Retinal fundus photograph:
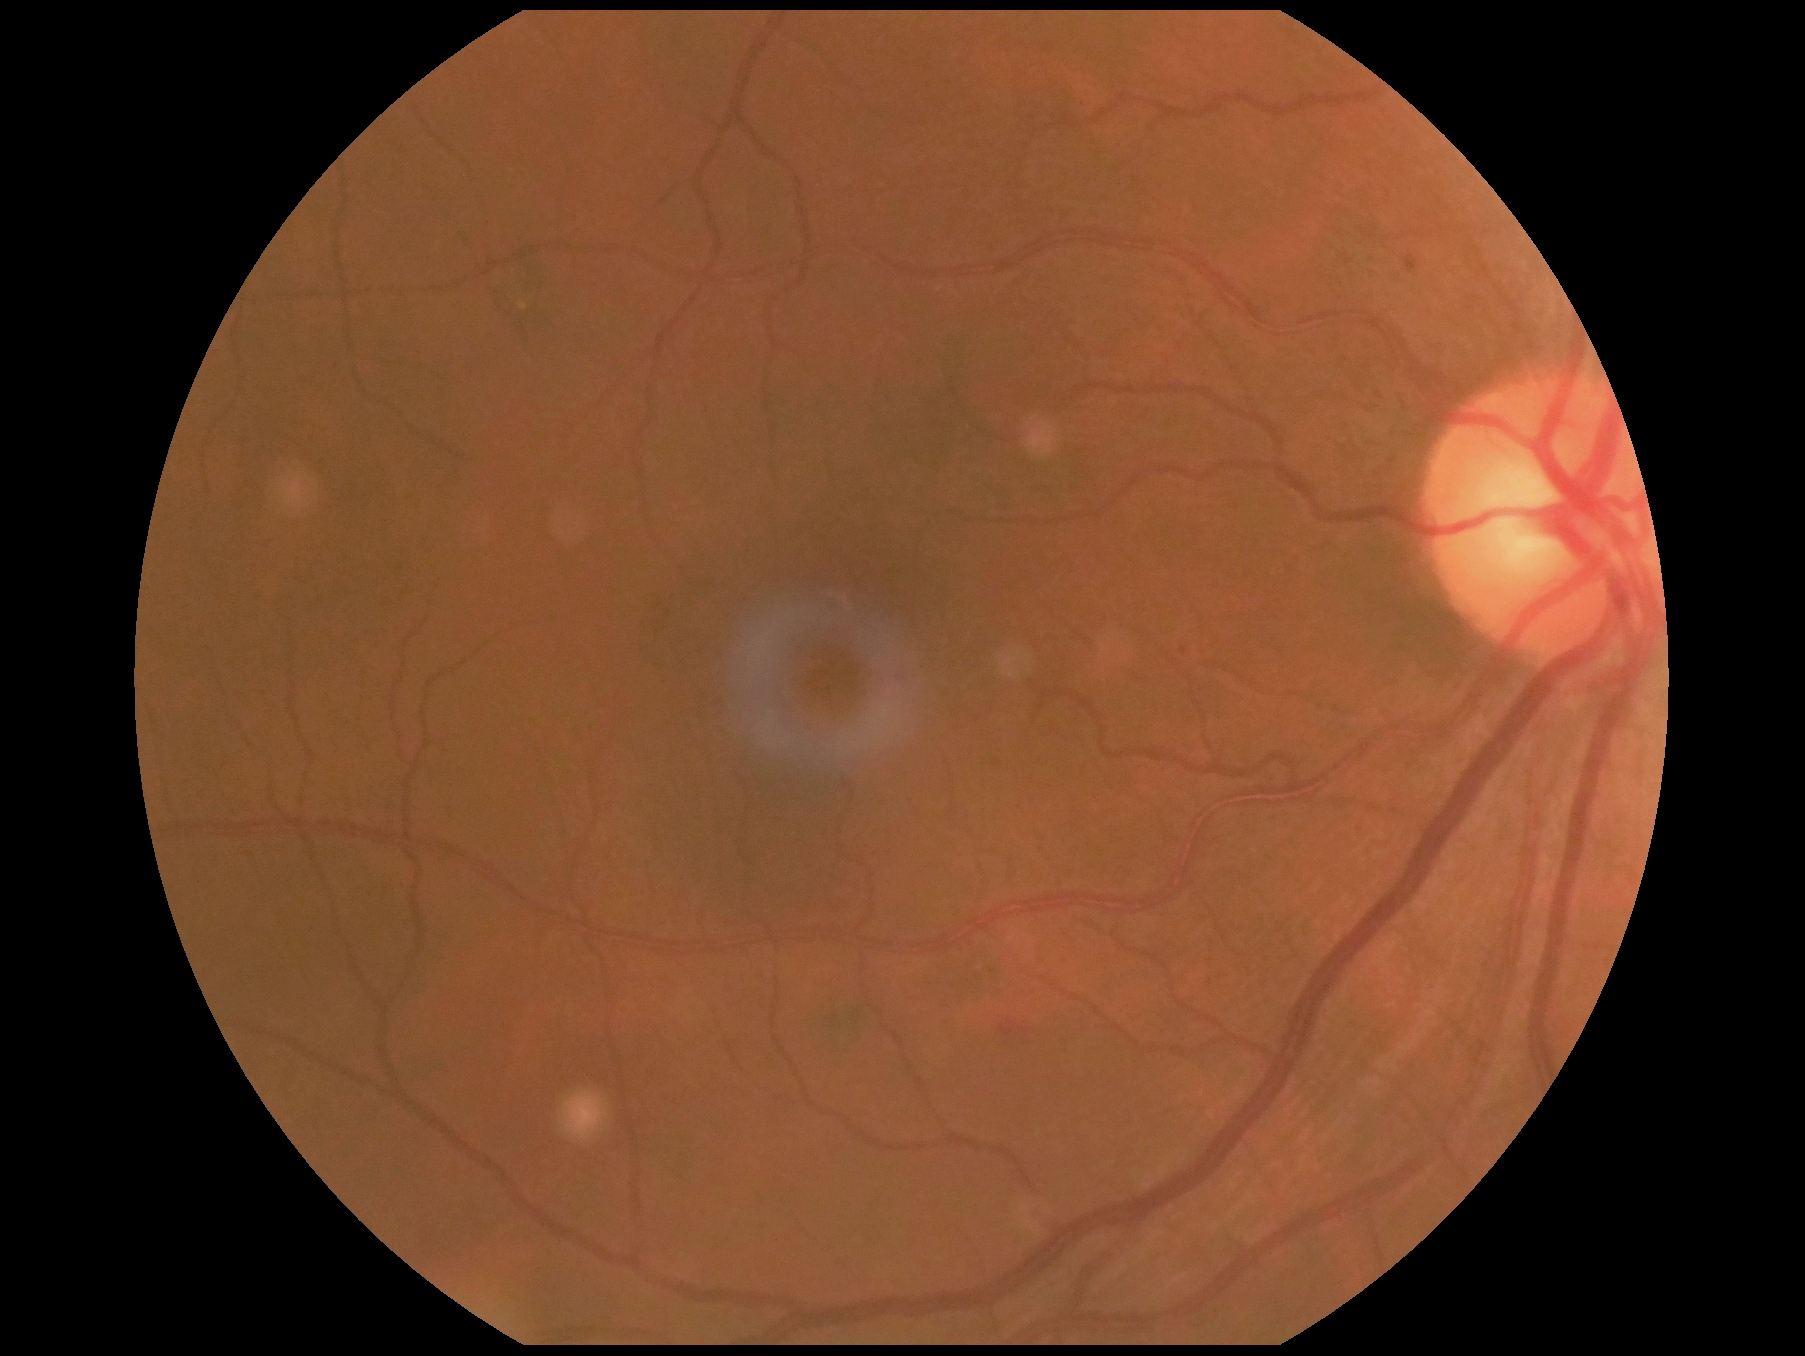
Diabetic retinopathy: grade 2 (moderate NPDR).